1659 by 2212 pixels: 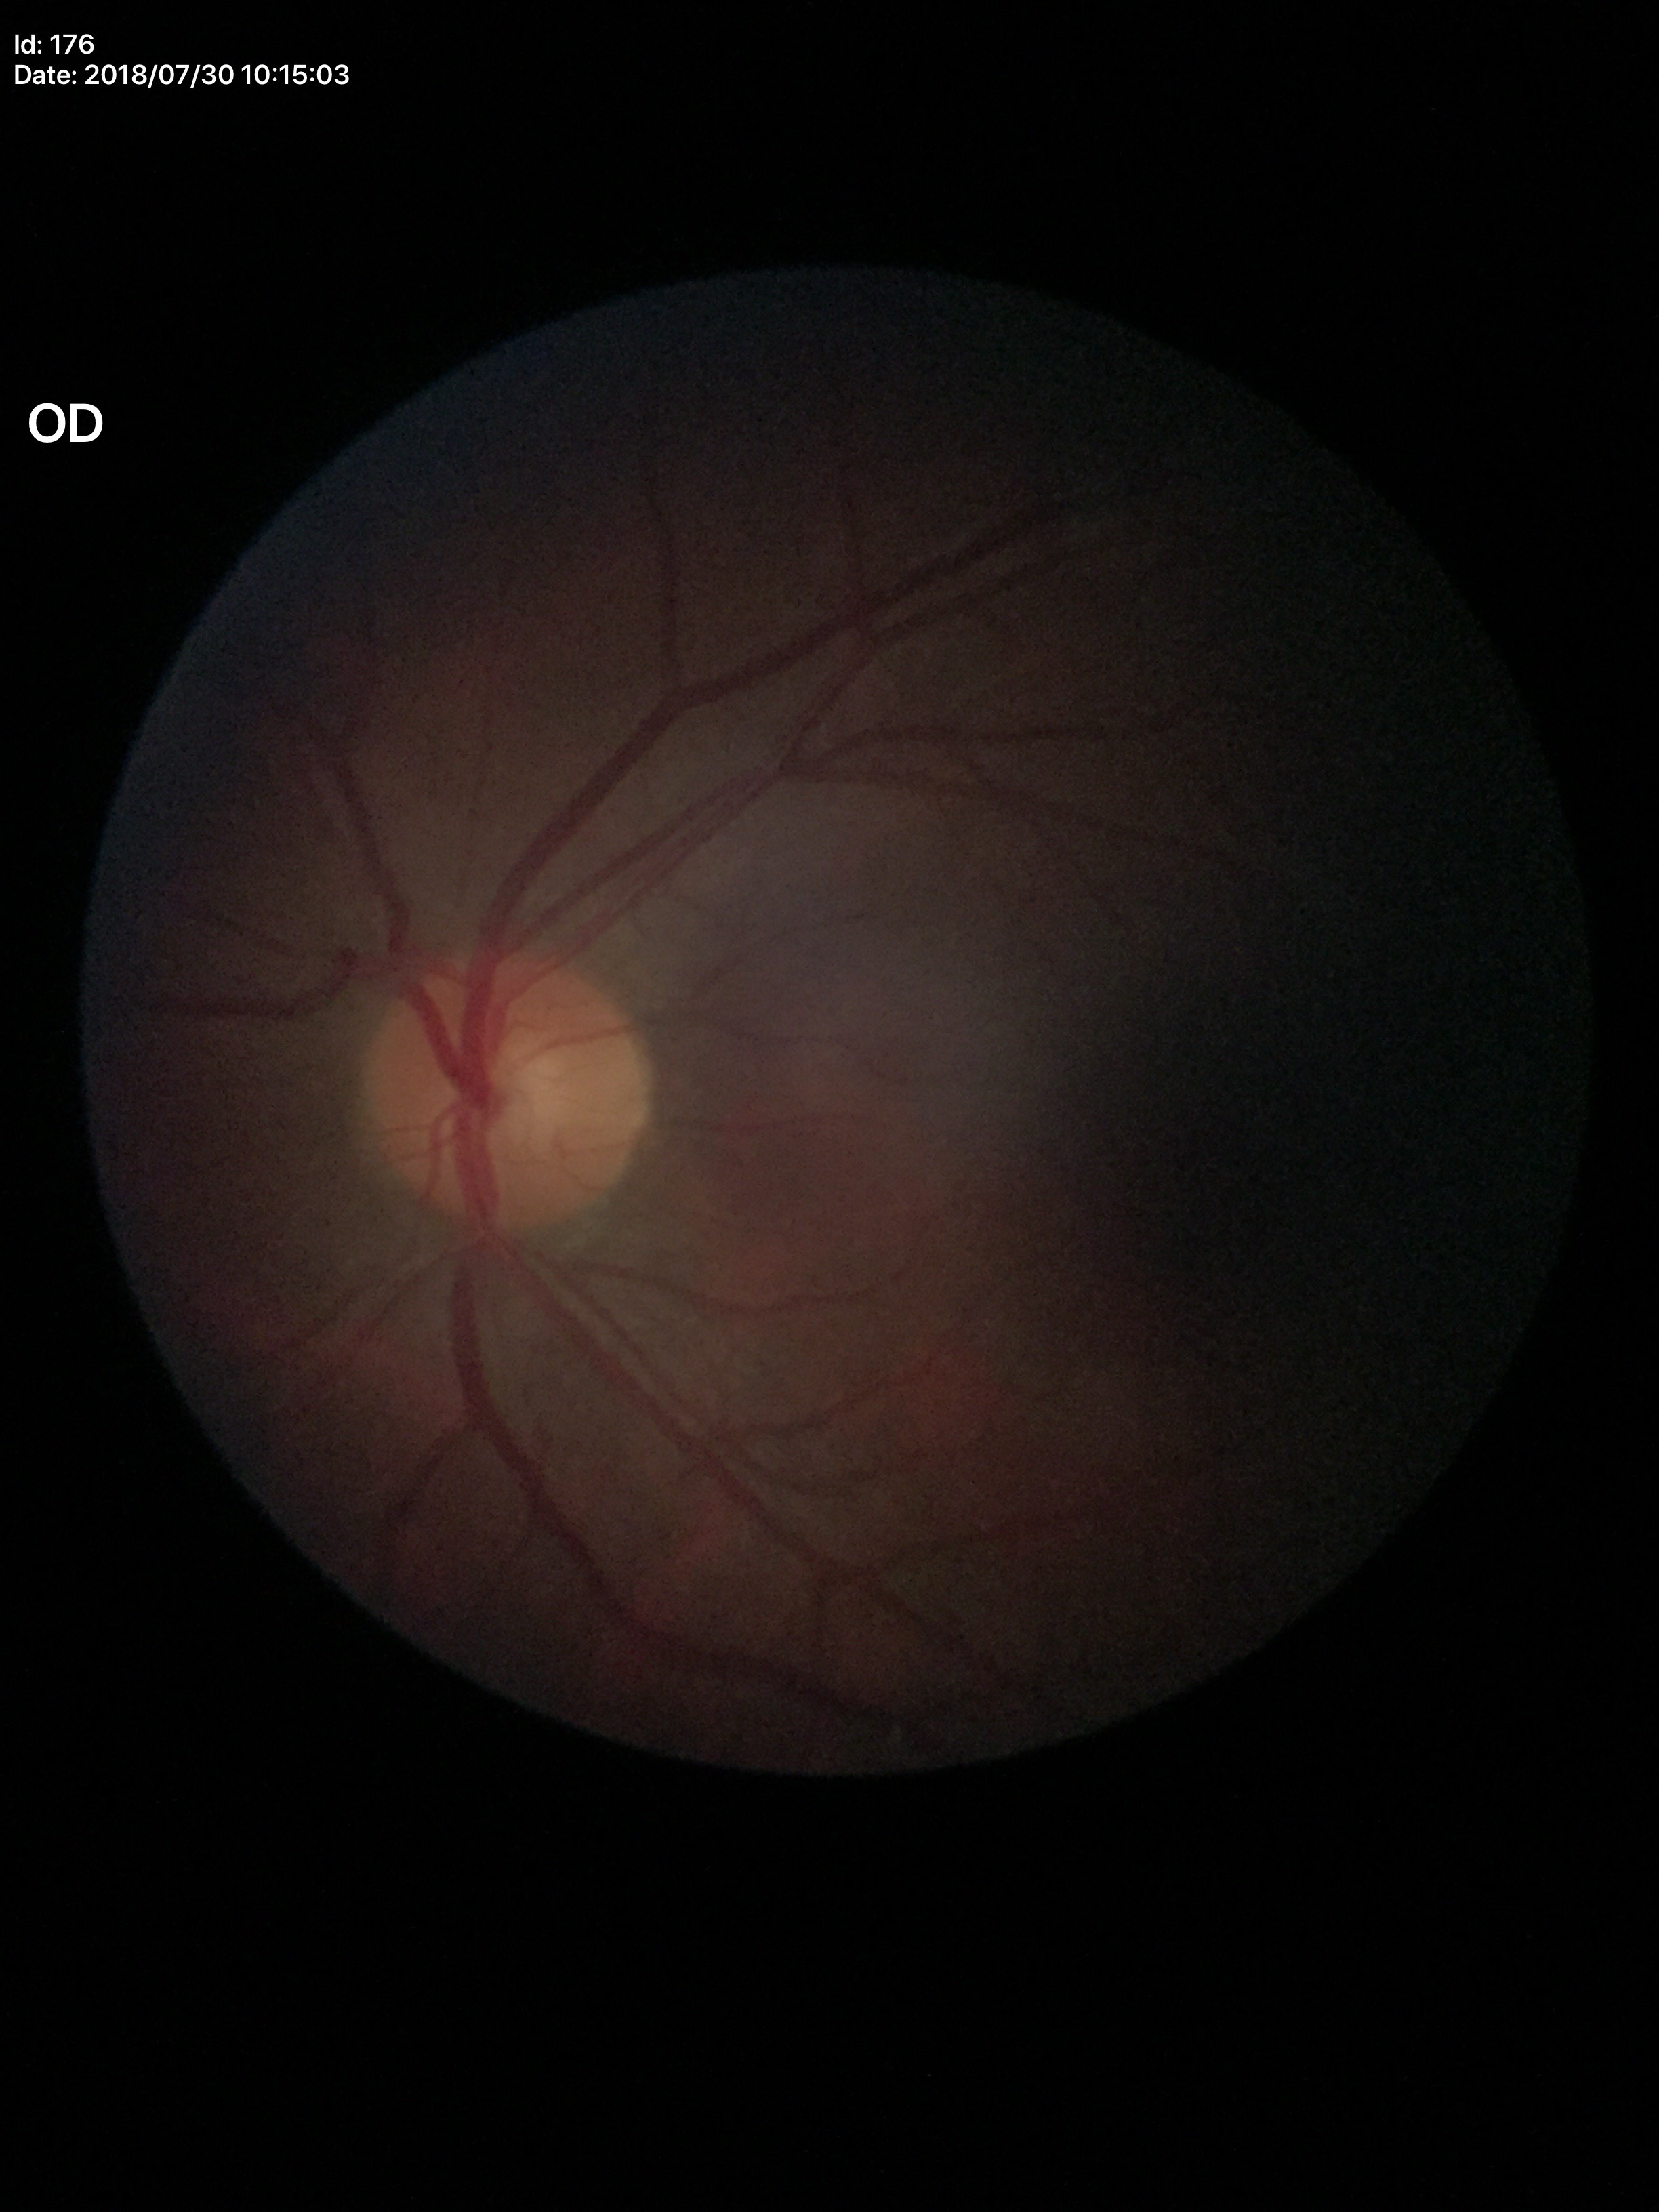
No glaucomatous optic neuropathy. Vertical cup-disc ratio (VCDR) is 0.49. Area cup-to-disc ratio (ACDR) of 0.22.